RetCam wide-field infant fundus image · 130° field of view (Natus RetCam Envision)
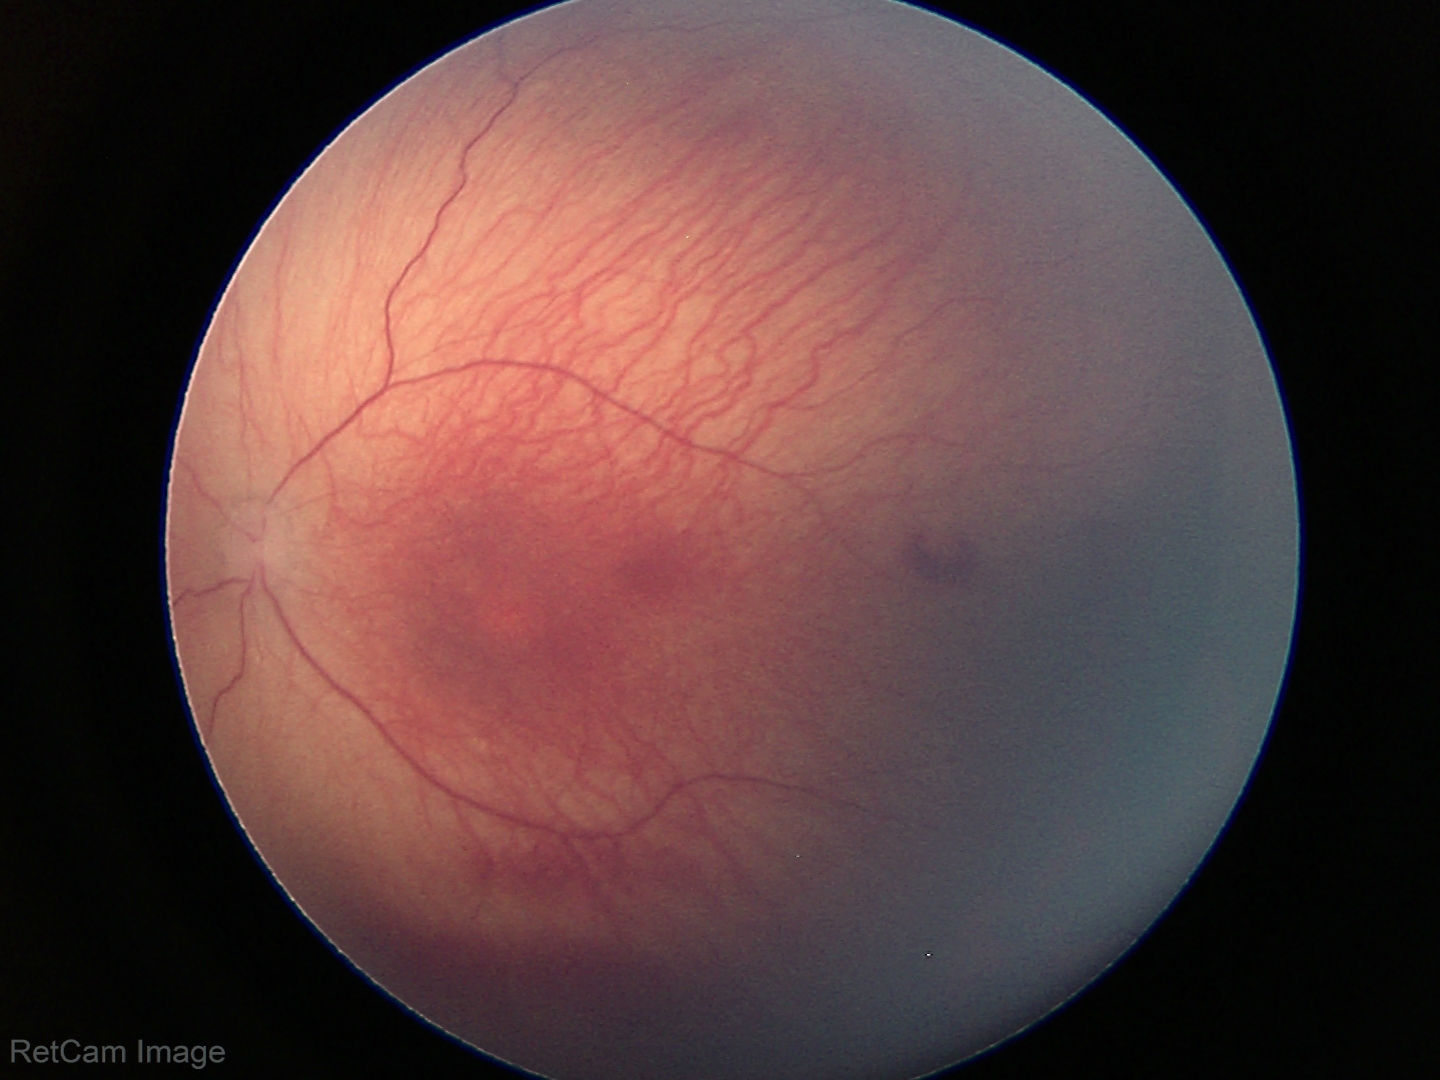

Screening series with ROP stage 1 — demarcation line between vascular and avascular retina.
No plus disease.